Wide-field fundus photograph from neonatal ROP screening · acquired on the Phoenix ICON · 1240x1240px.
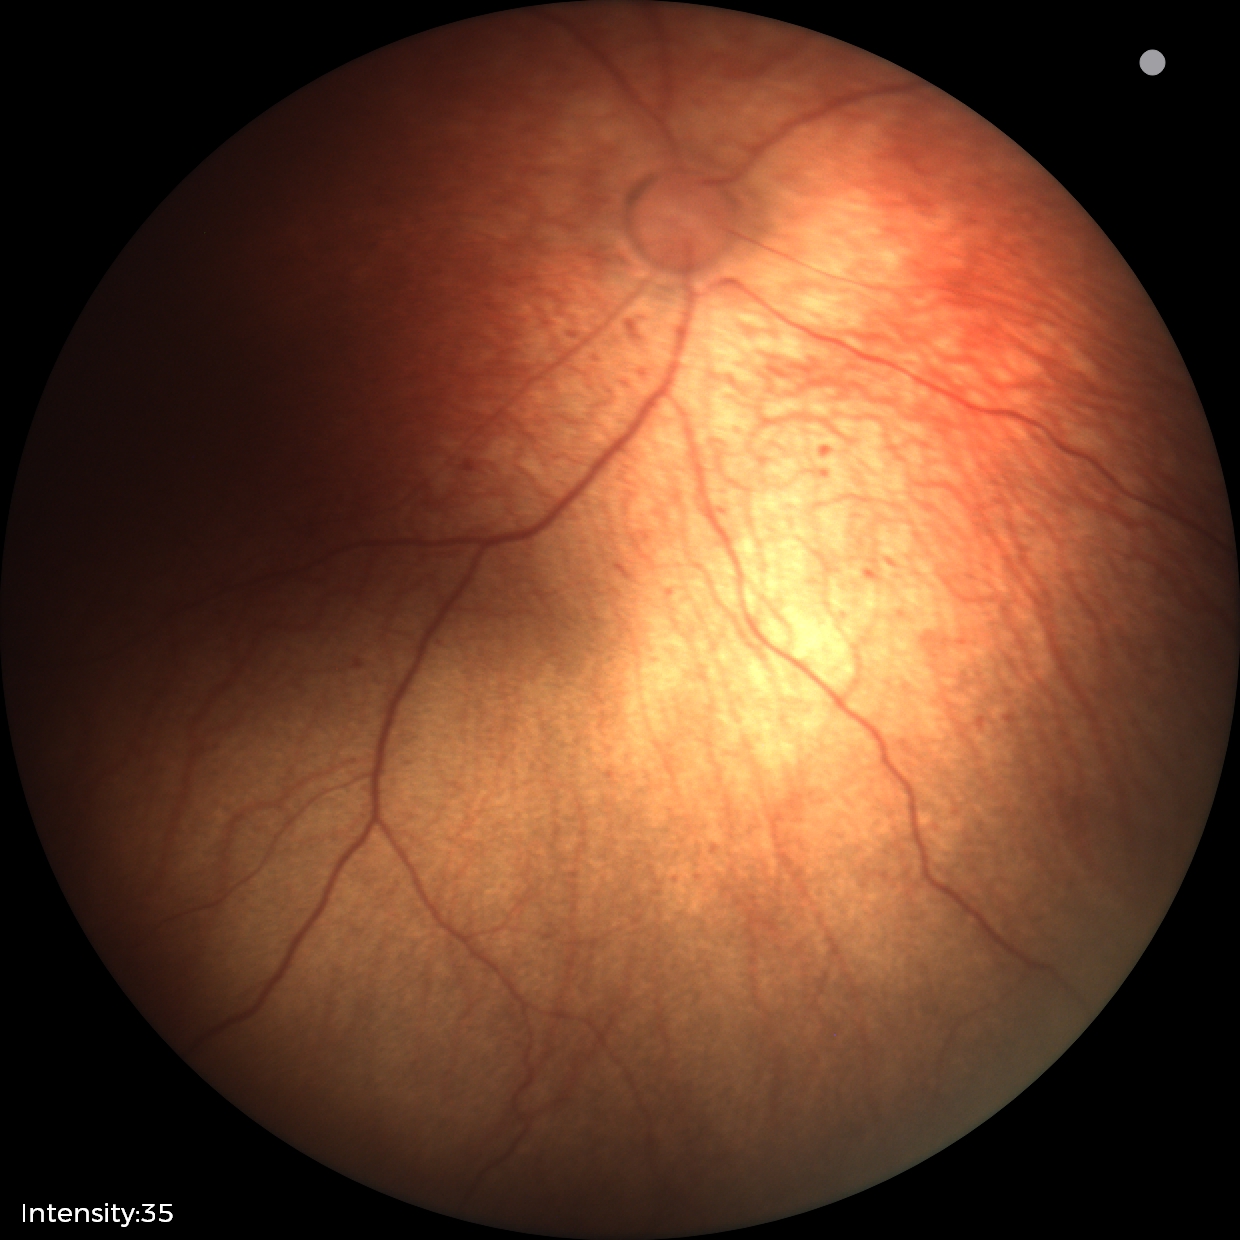
Screening: no plus disease — posterior pole vessels without abnormal dilation or tortuosity | status post retinopathy of prematurity (ROP).